Captured with the Phoenix ICON (100° field of view) · wide-field fundus image from infant ROP screening — 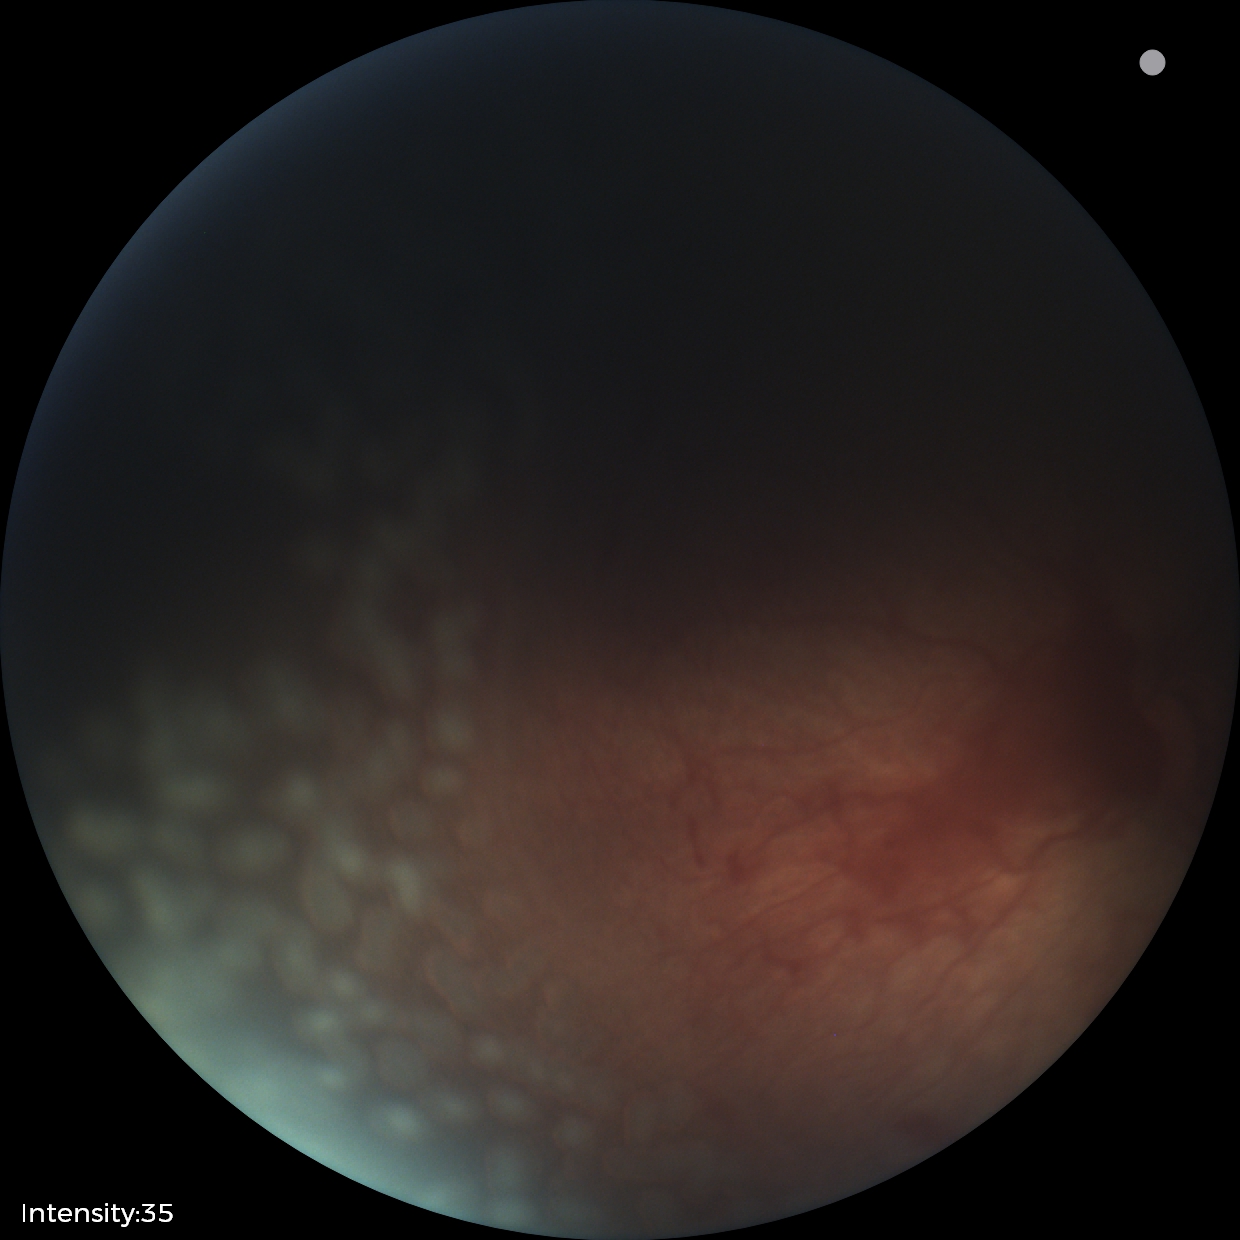
Screening examination consistent with ROP stage 2 — ridge with height and width at the demarcation line.